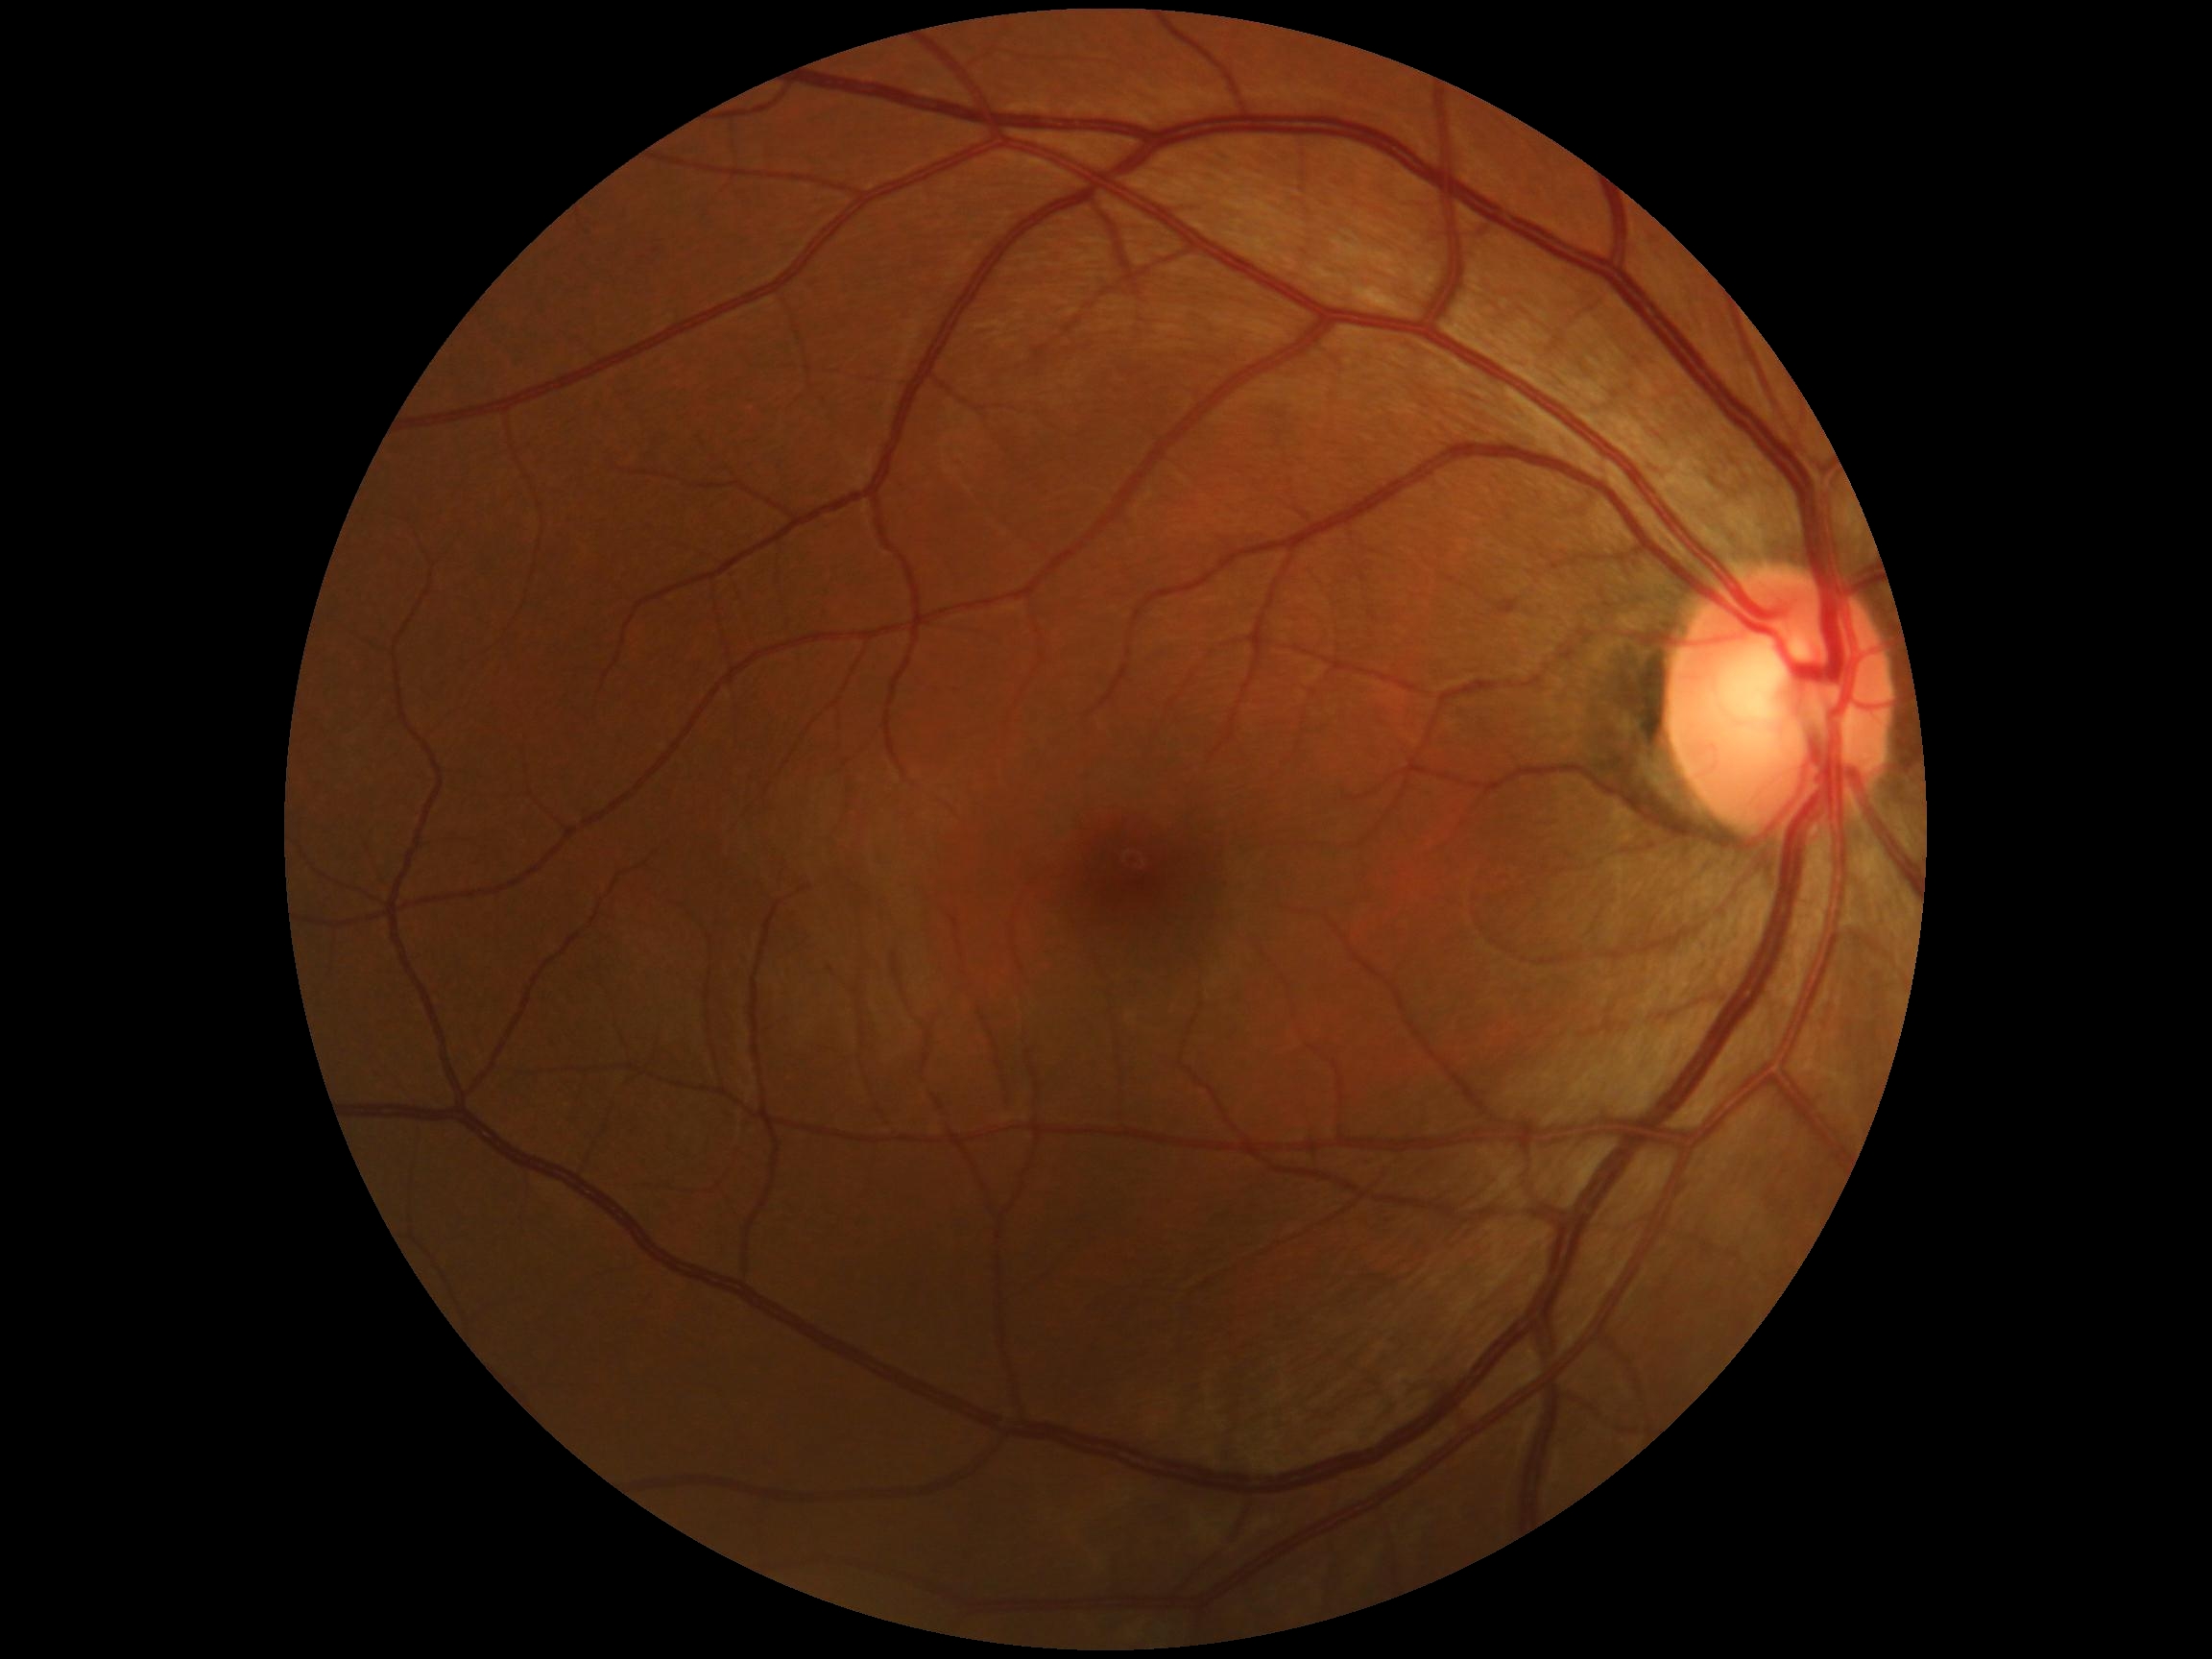 diabetic retinopathy = grade 0 — no visible signs of diabetic retinopathy